Infant wide-field fundus photograph
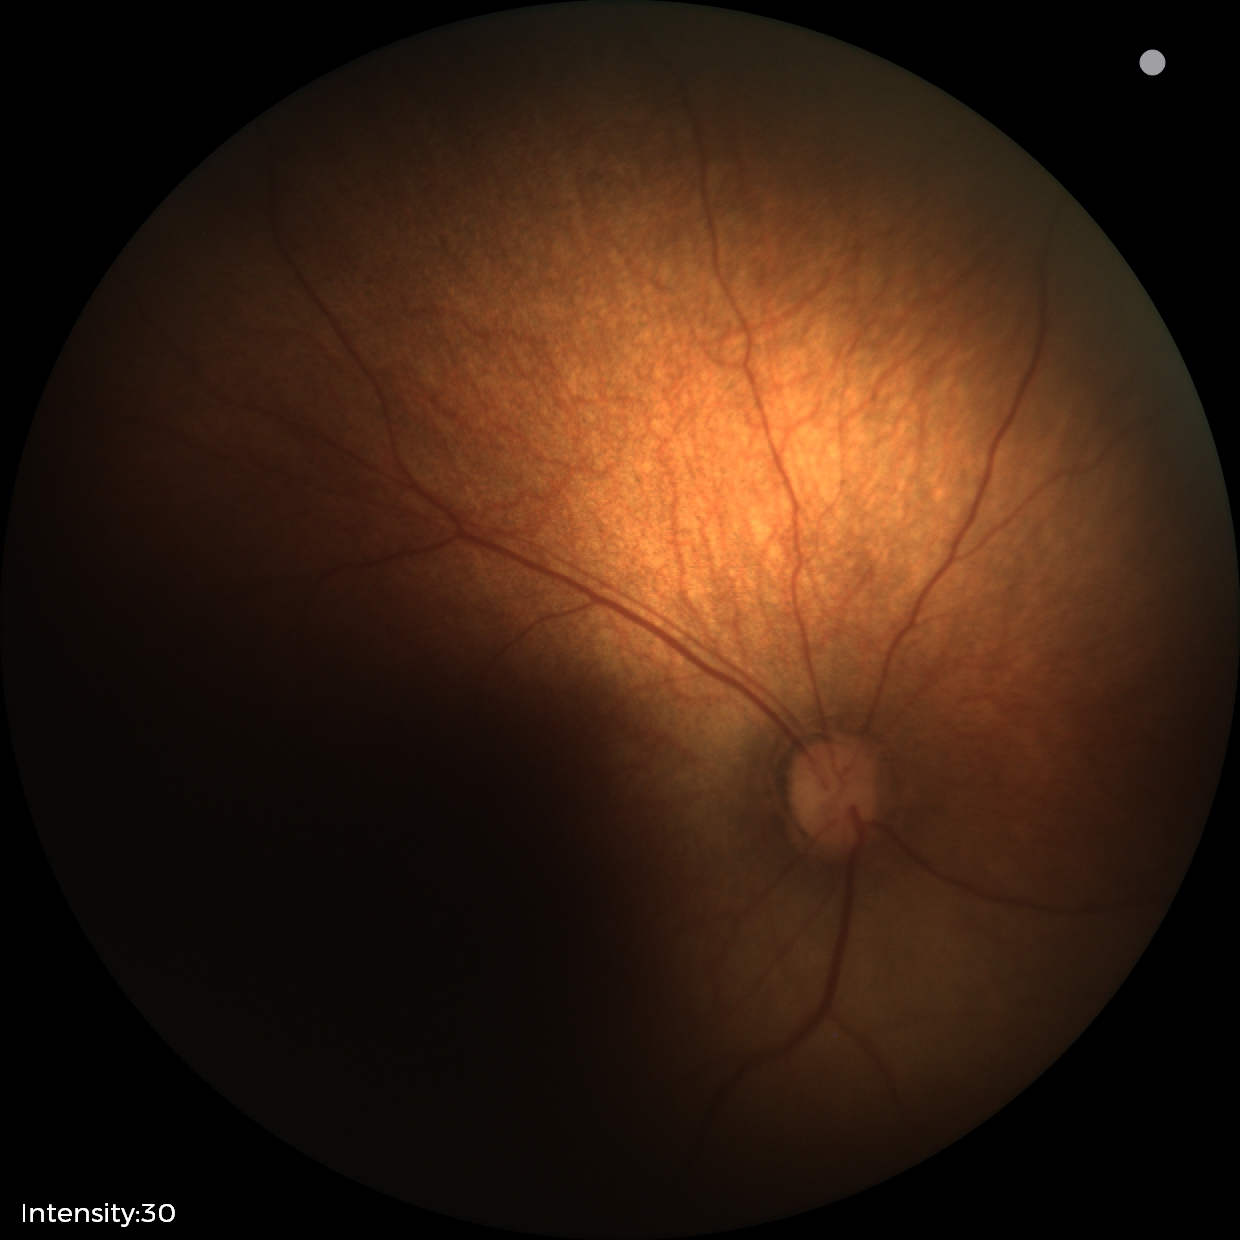
Finding: normal.